NIDEK AFC-230. Color fundus photograph. 45-degree field of view. Nonmydriatic fundus photograph. DR severity per modified Davis staging.
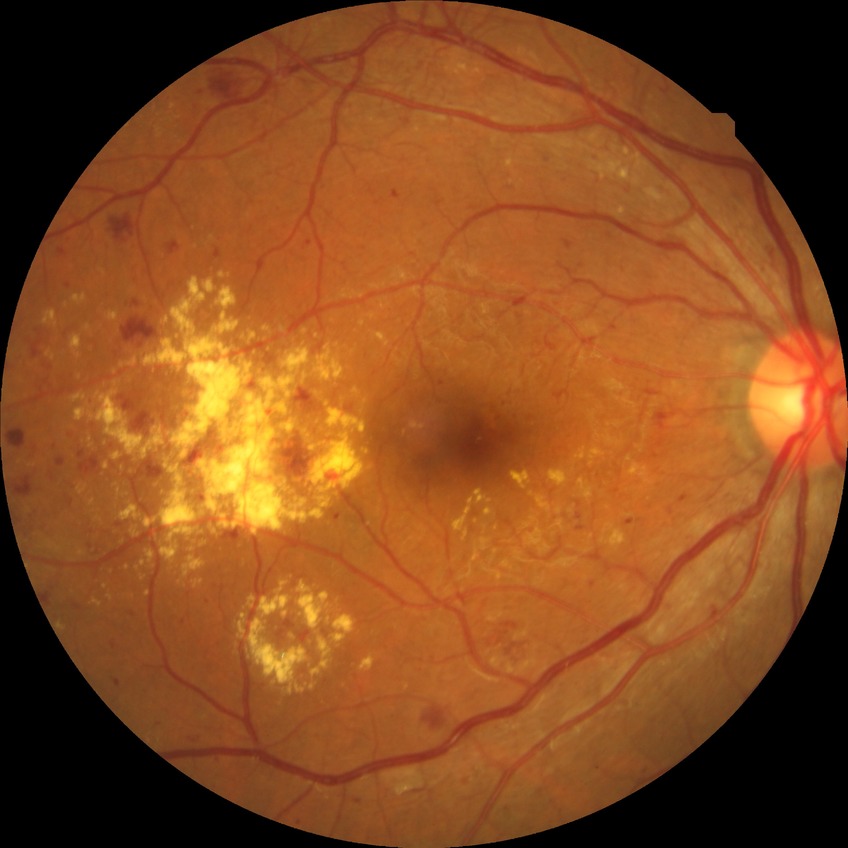
retinopathy grade=proliferative diabetic retinopathy.